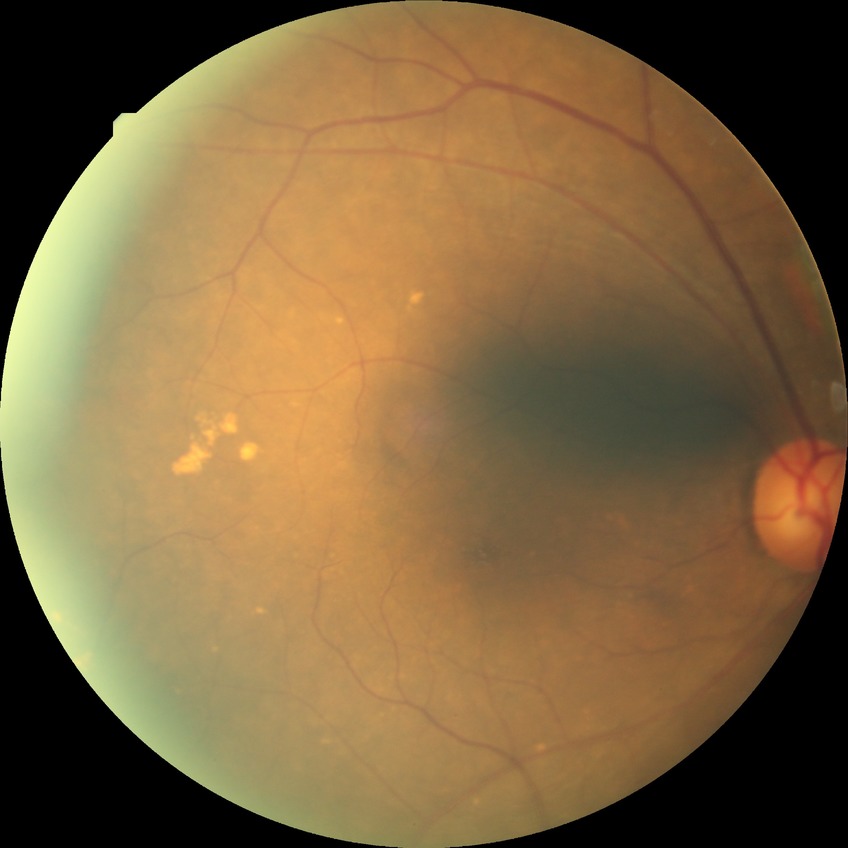

Diabetic retinopathy (DR): no diabetic retinopathy (NDR).